Camera: Clarity RetCam 3 (130° FOV). Wide-field fundus image from infant ROP screening
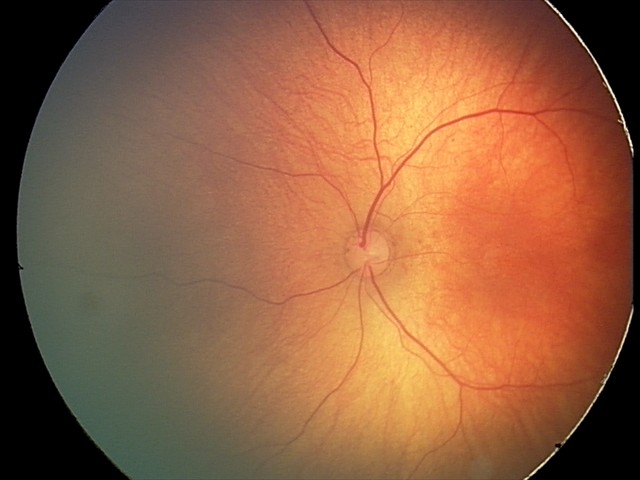 Q: What is the diagnosis from this examination?
A: physiological retinal finding